Acquired with a NIDEK AFC-230 — 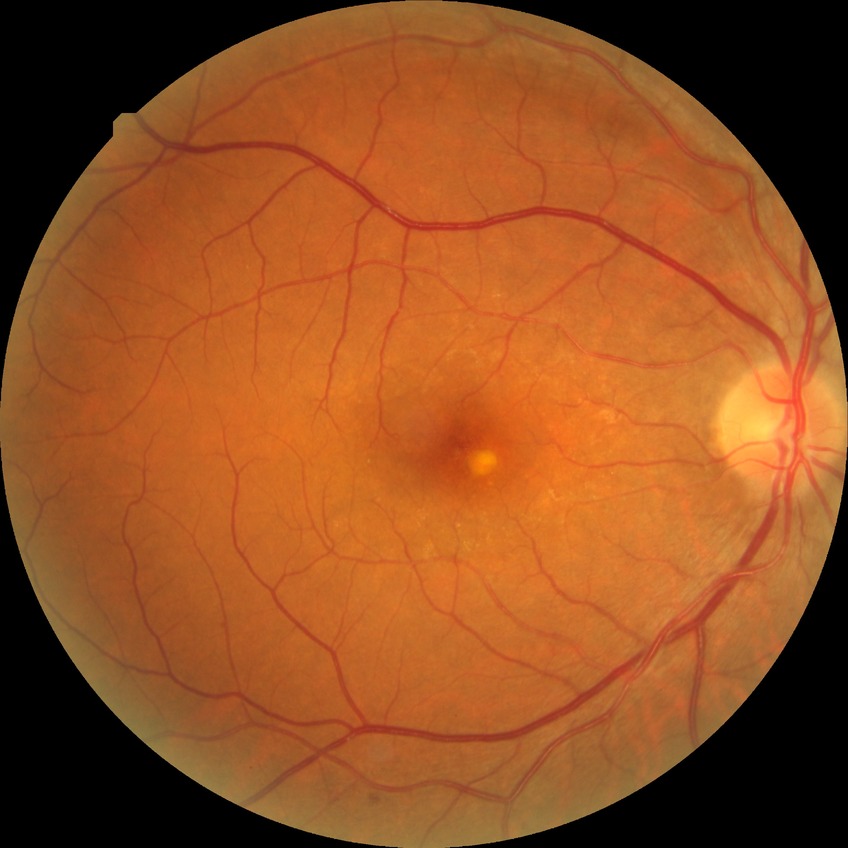
Diabetic retinopathy (DR) is no diabetic retinopathy (NDR).